Davis DR grading — 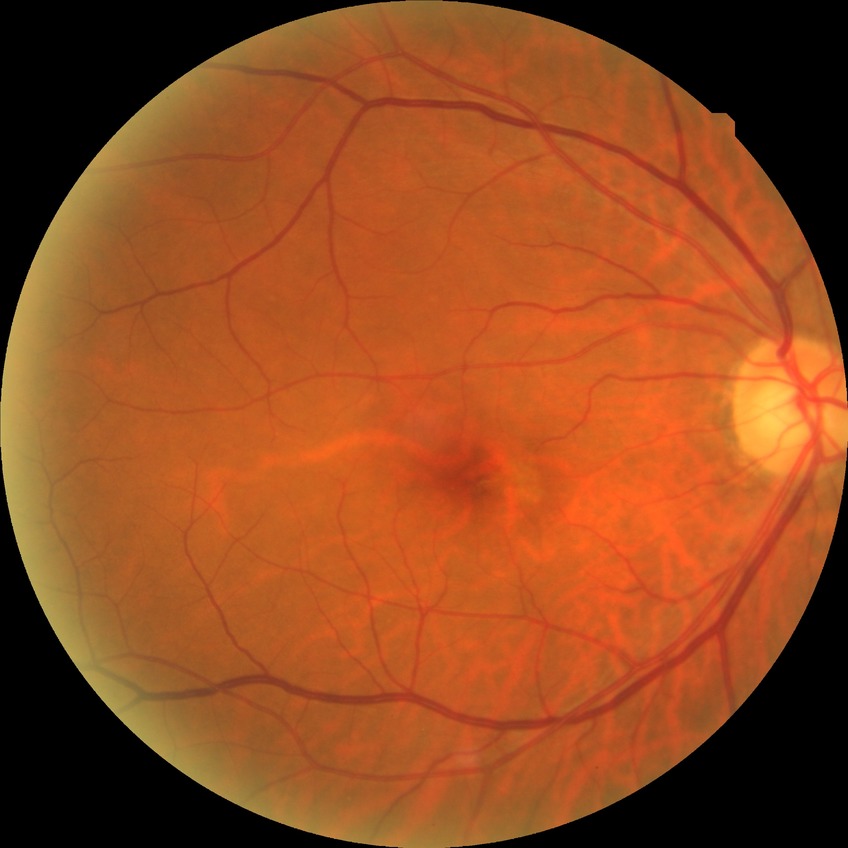

retinopathy grade = no diabetic retinopathy.